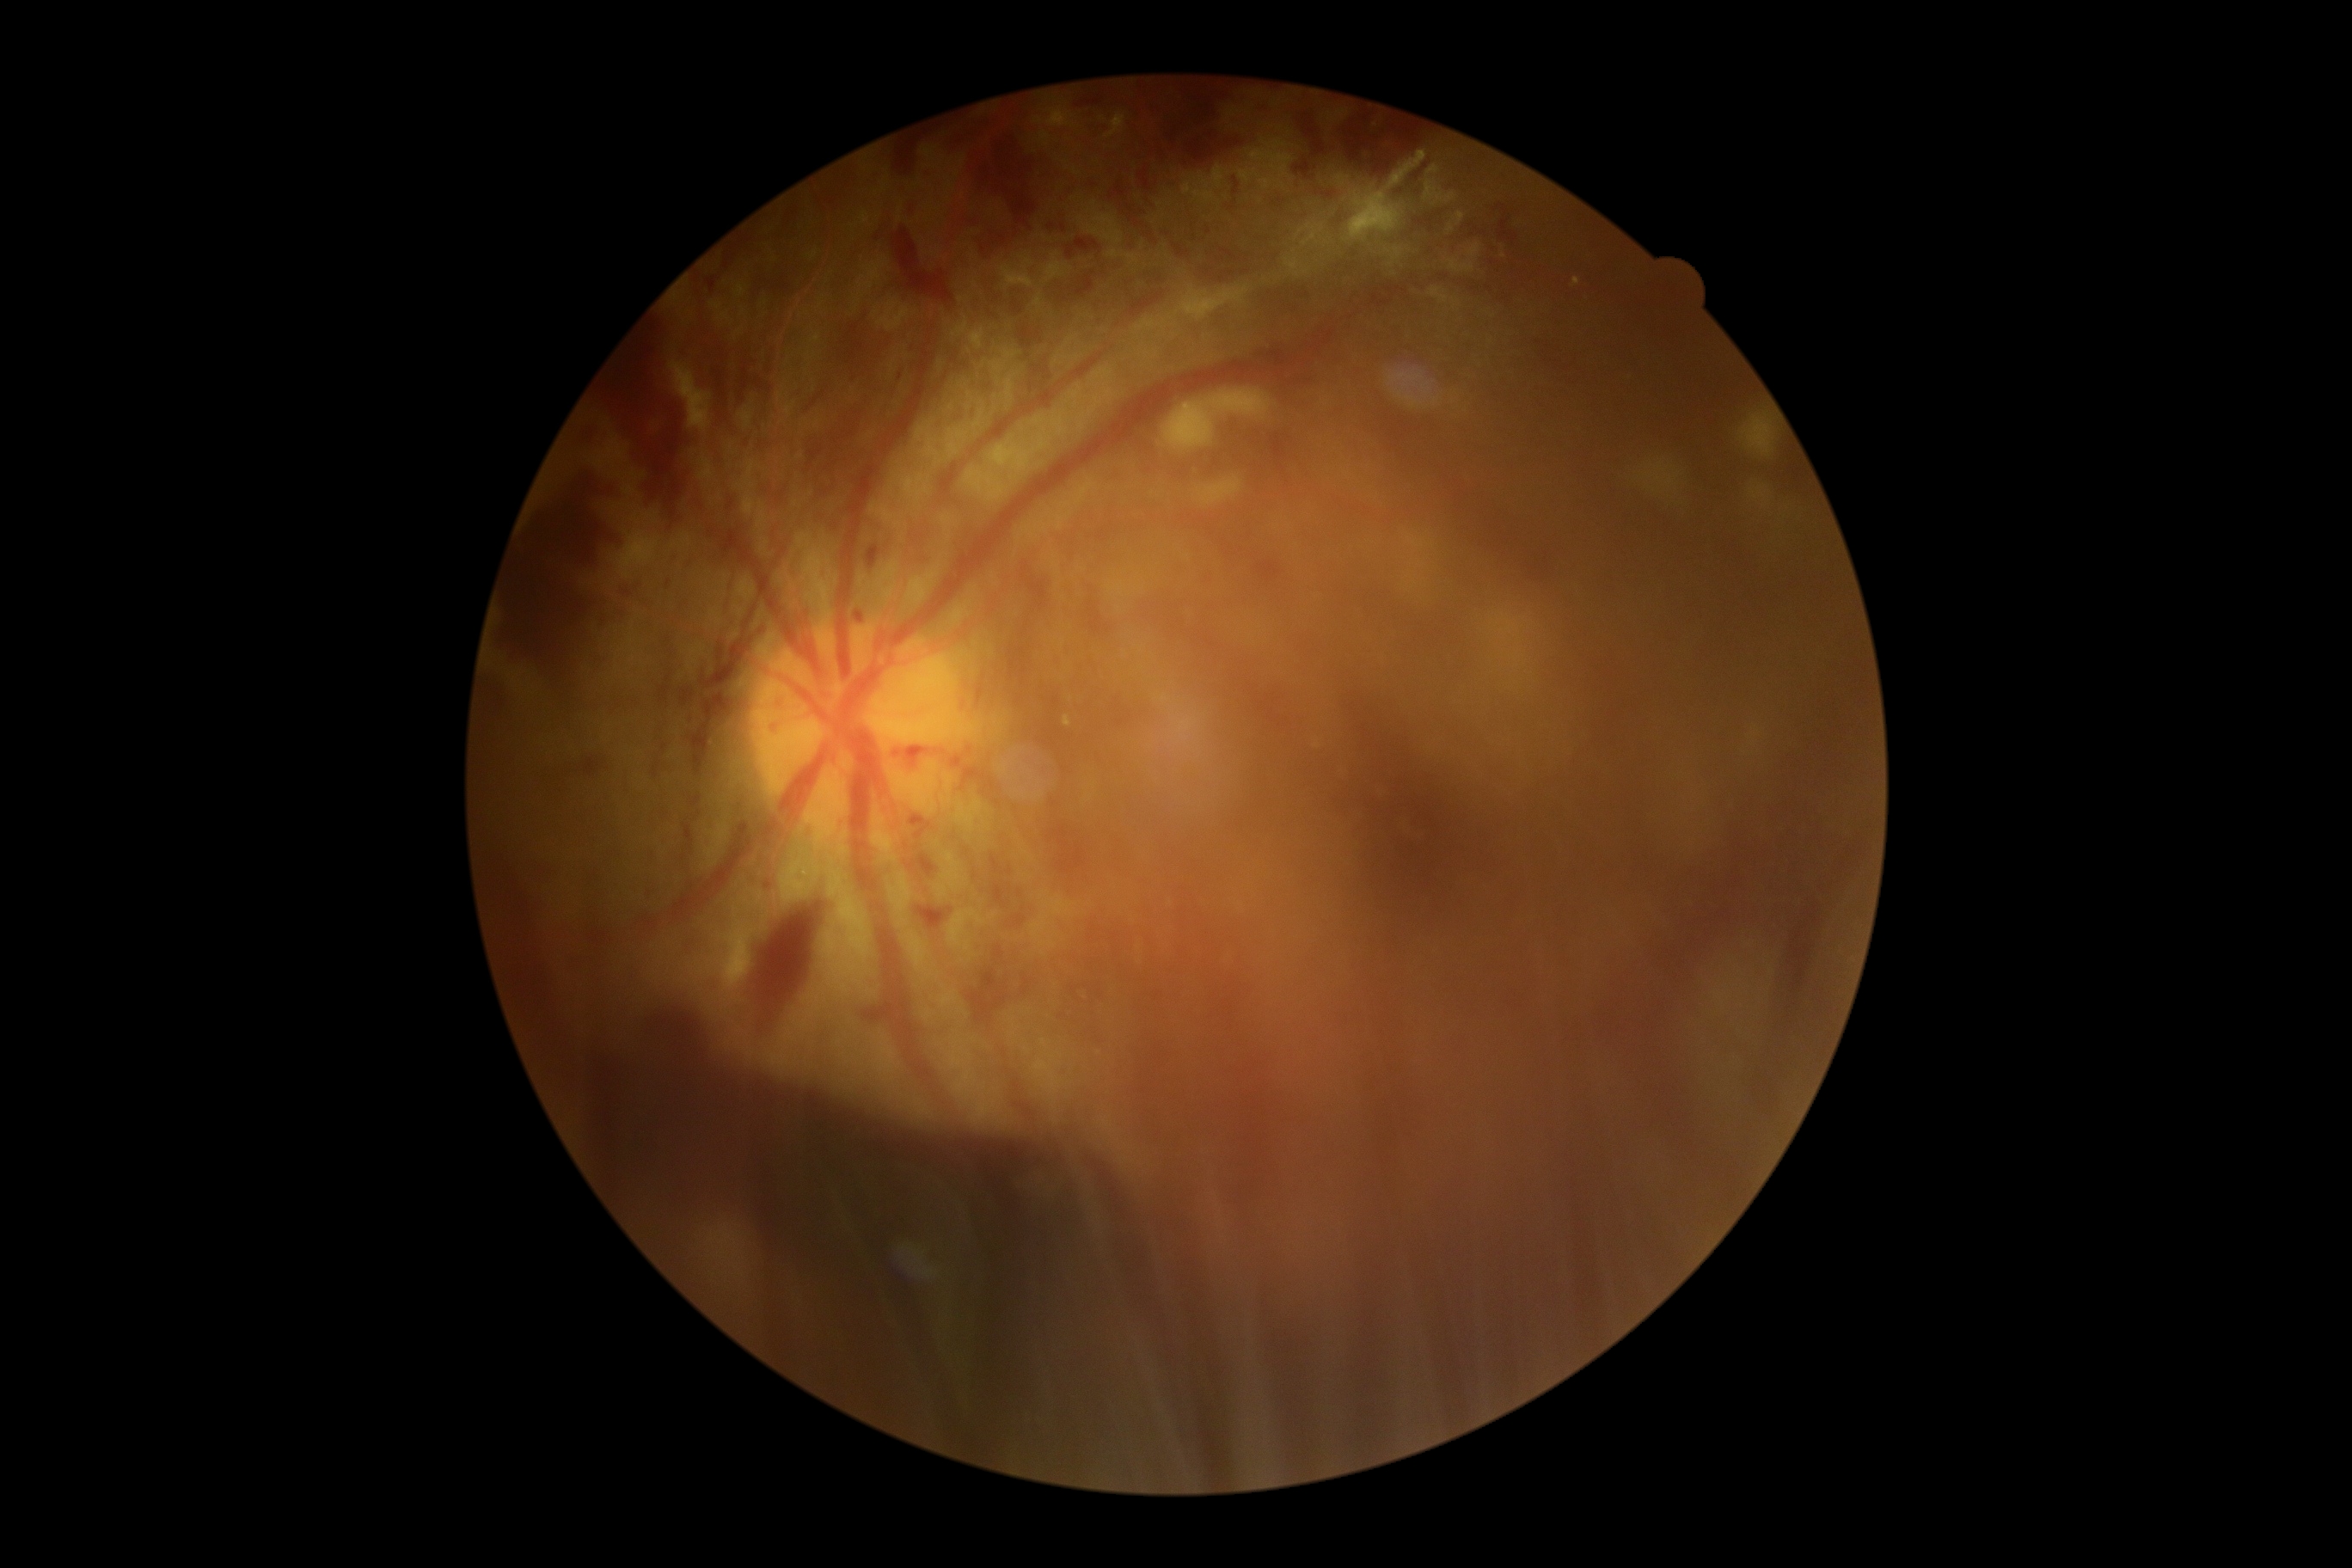 diabetic retinopathy severity: 4/4.